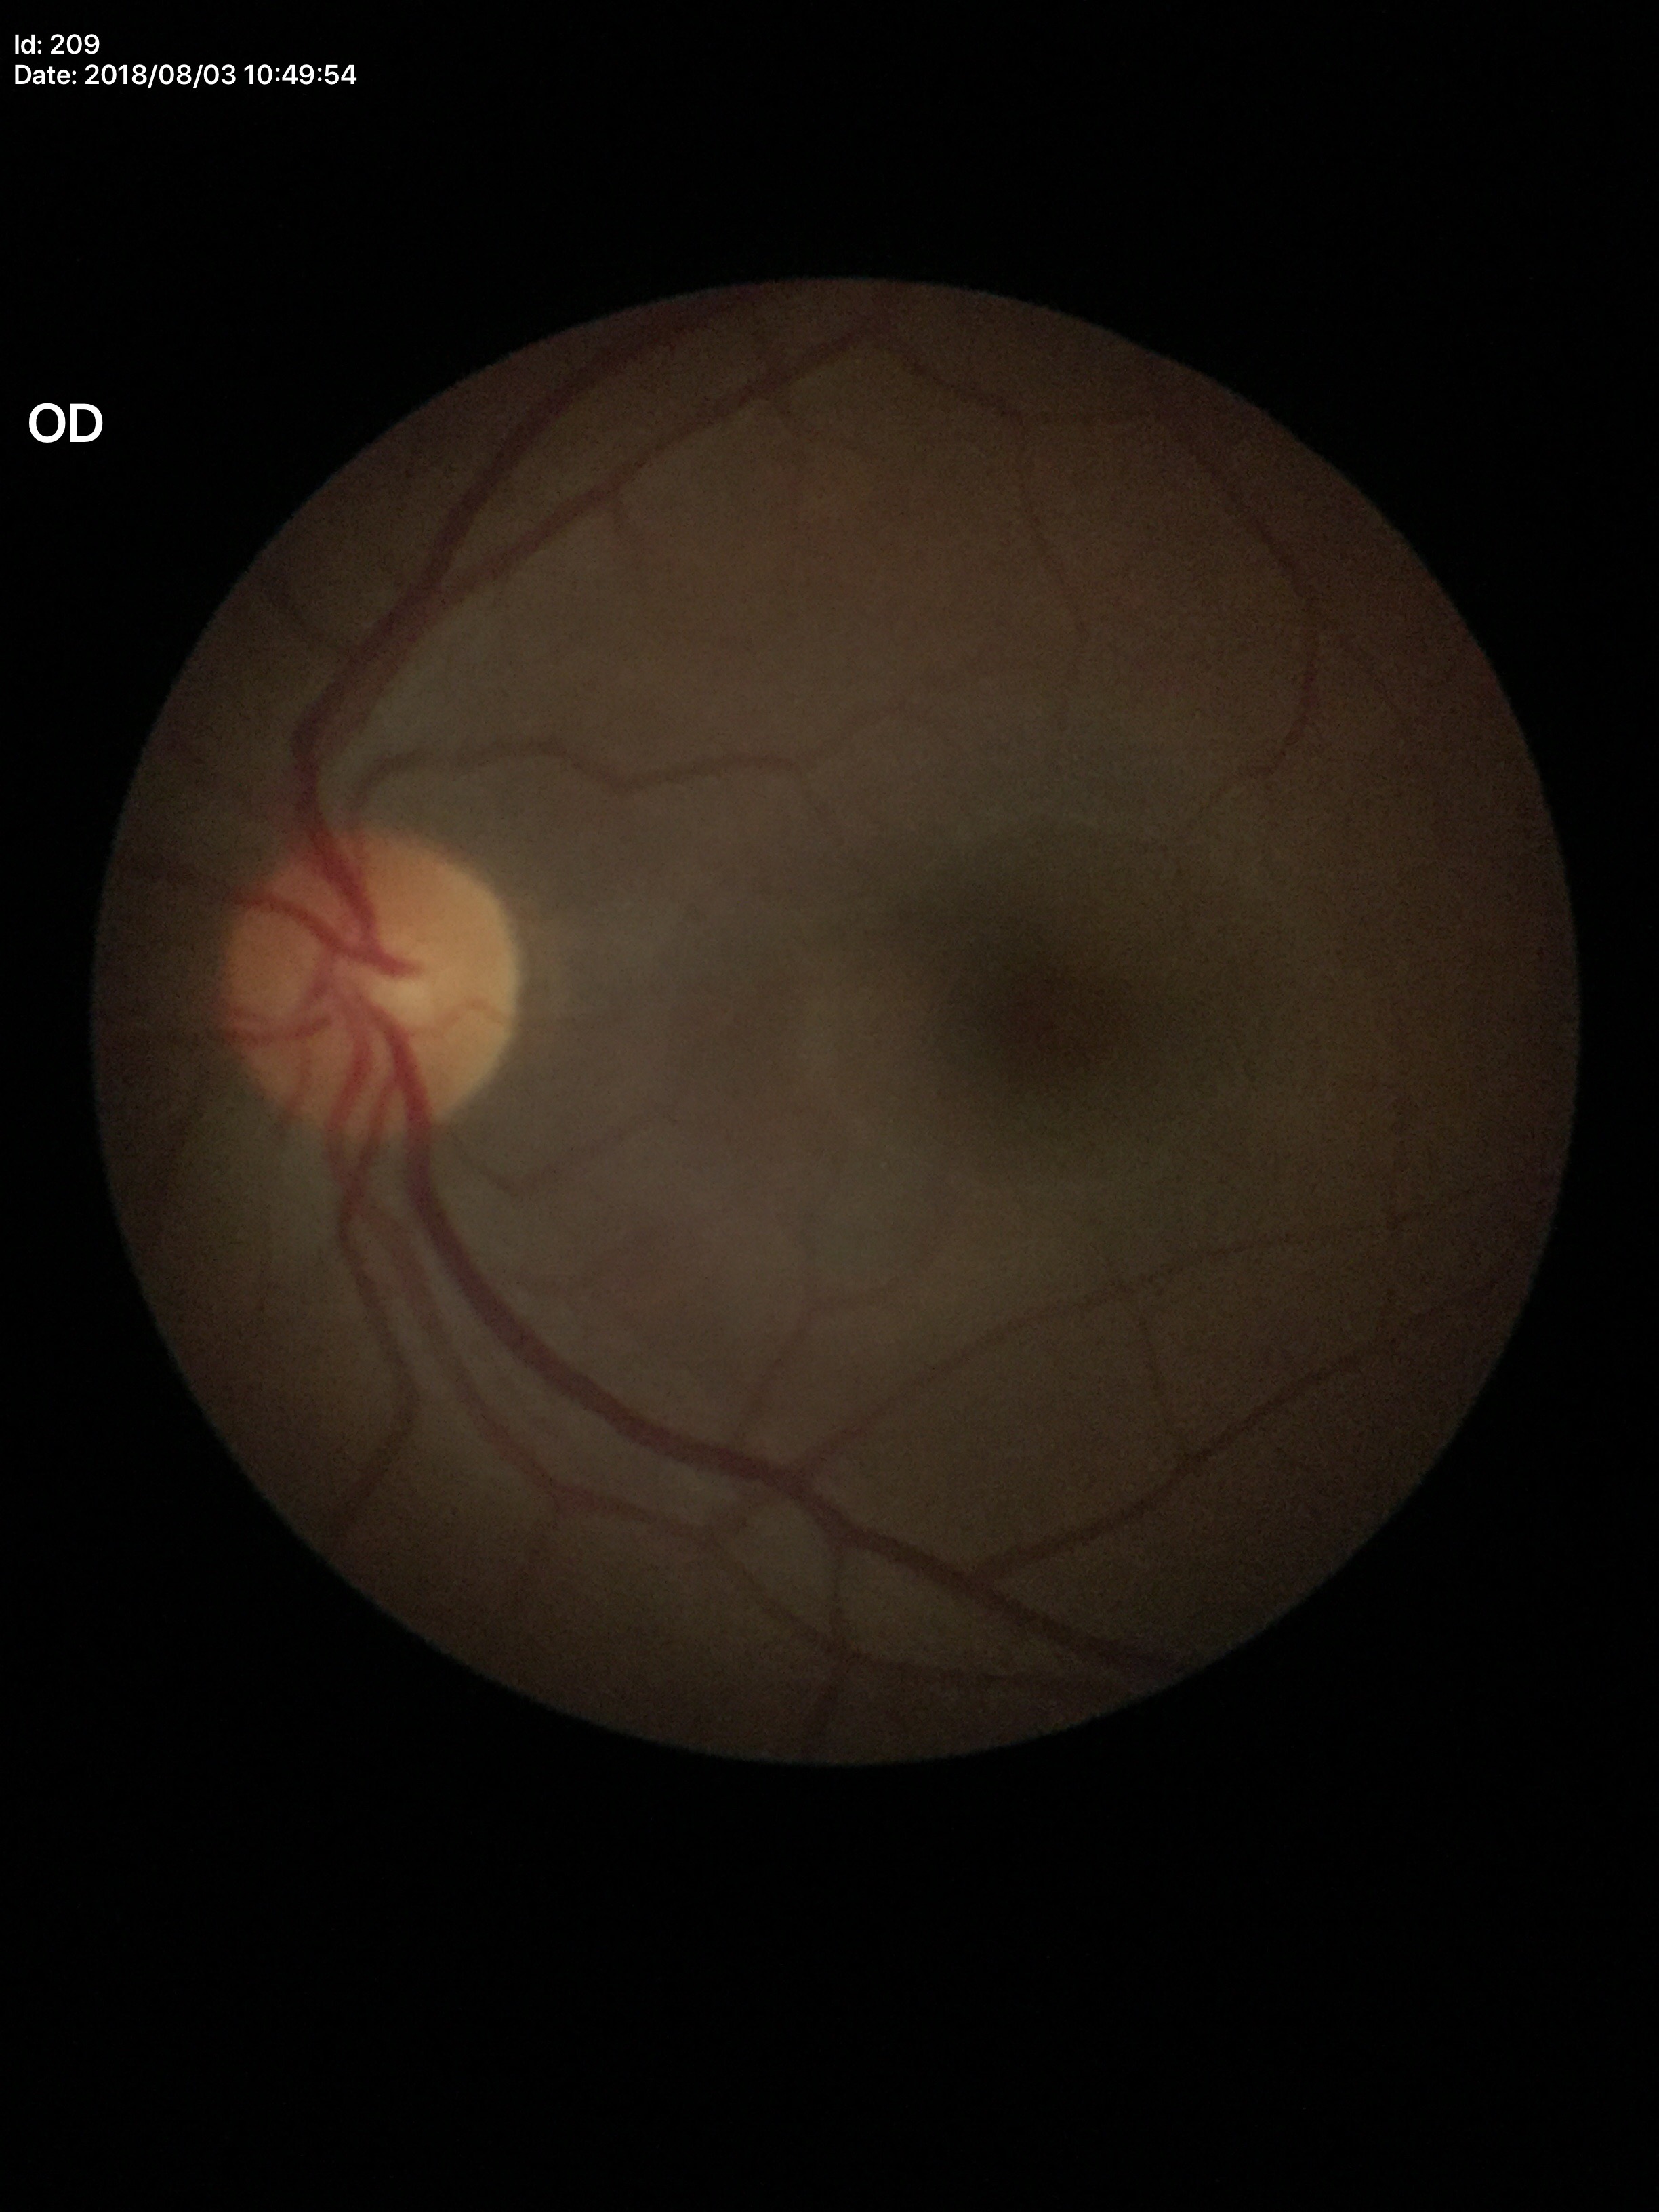

Glaucoma impression: negative. HCDR of 0.45. VCDR is 0.39.